1932x1932: 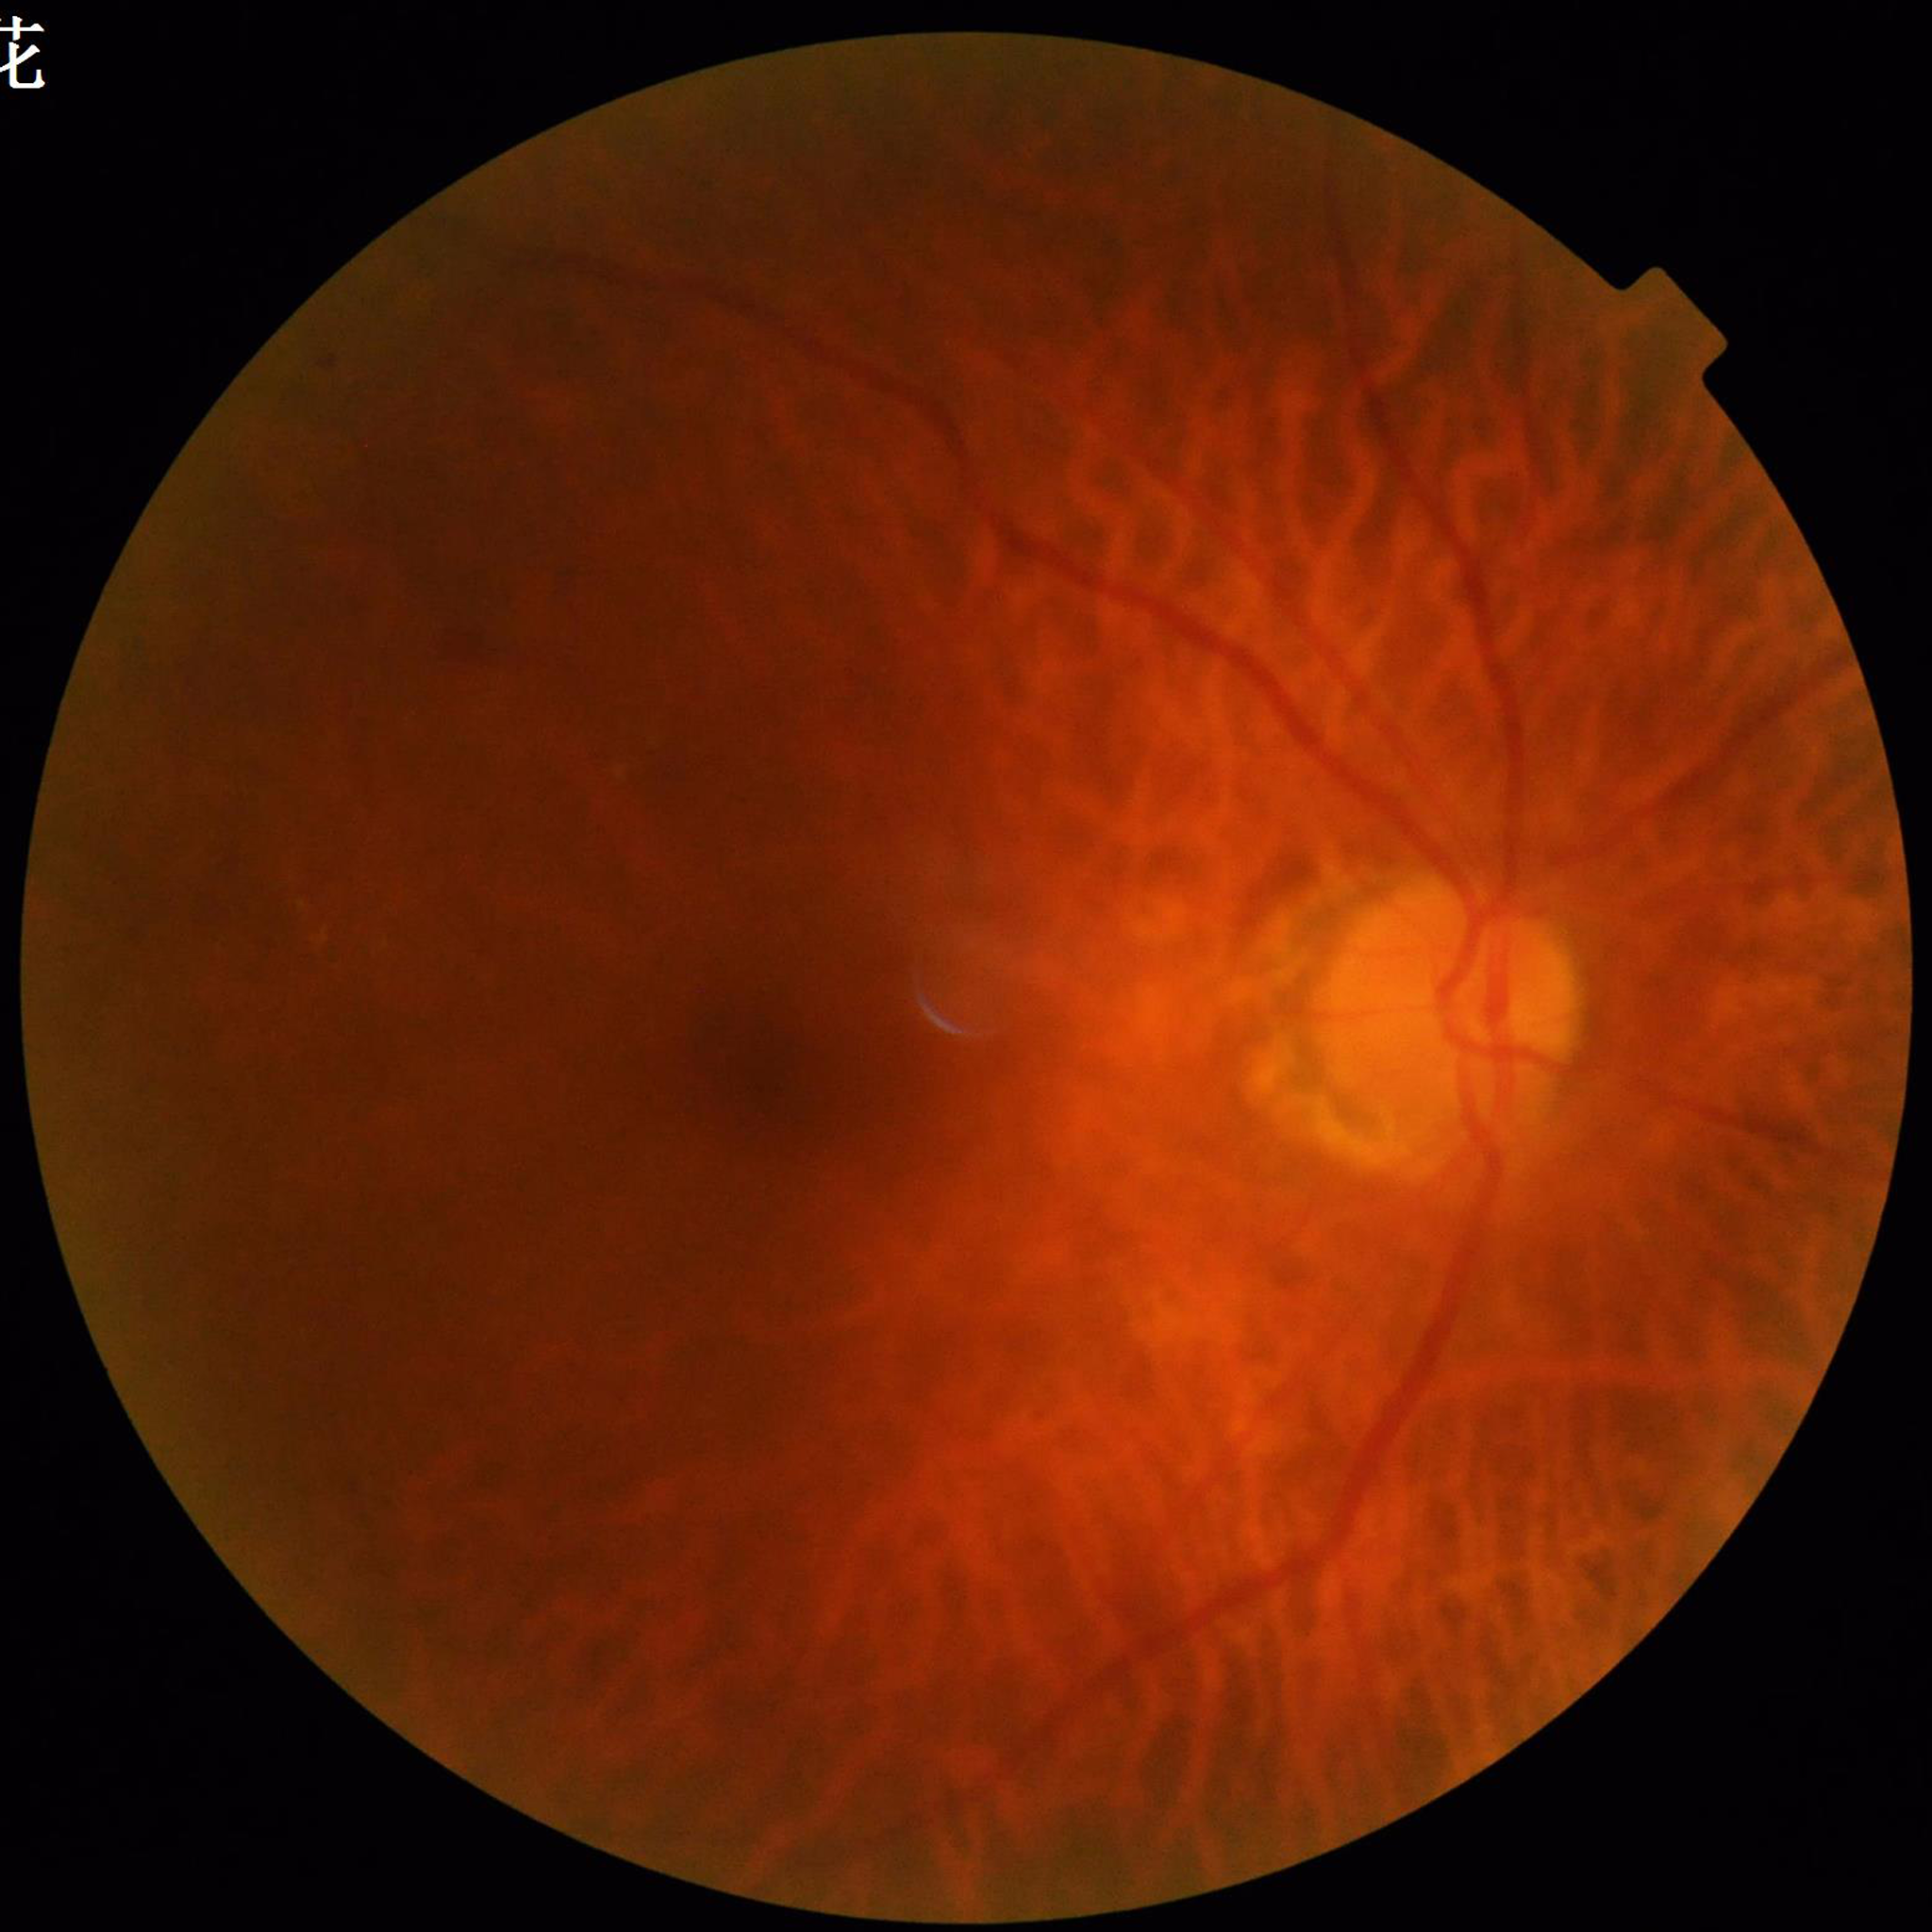
This fundus photograph is from a patient diagnosed with diabetic retinopathy.